NIDEK AFC-230 · nonmydriatic fundus photograph · image size 848x848.
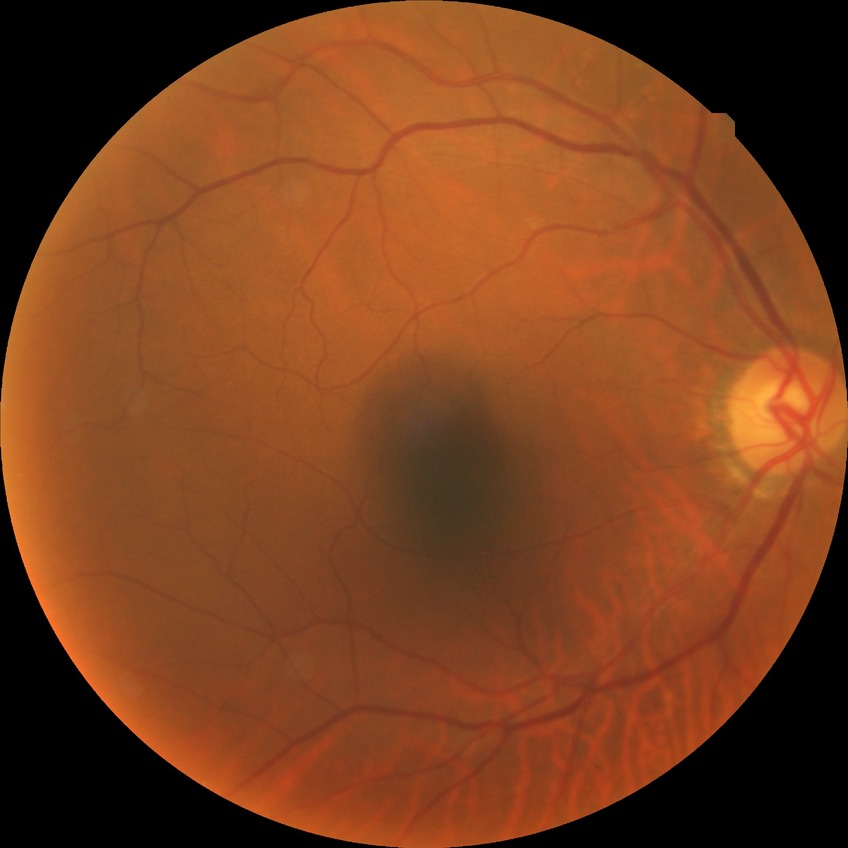

diabetic retinopathy (DR)@no diabetic retinopathy (NDR).